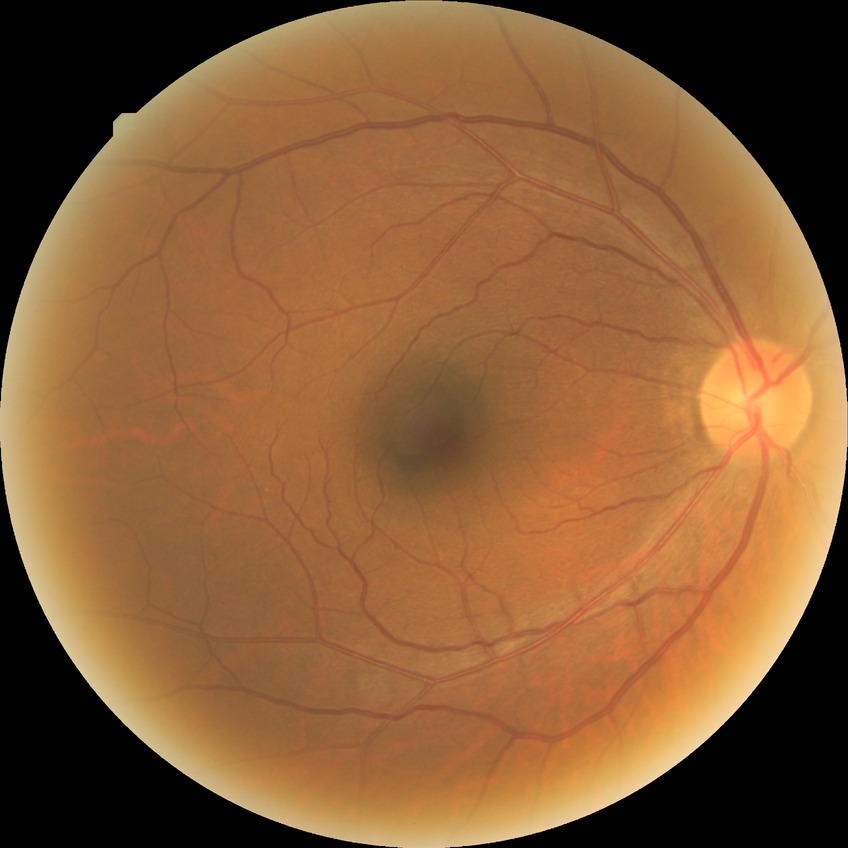

Diabetic retinopathy severity: no diabetic retinopathy.